45 degree fundus photograph, posterior pole photograph, 848x848, NIDEK AFC-230 fundus camera:
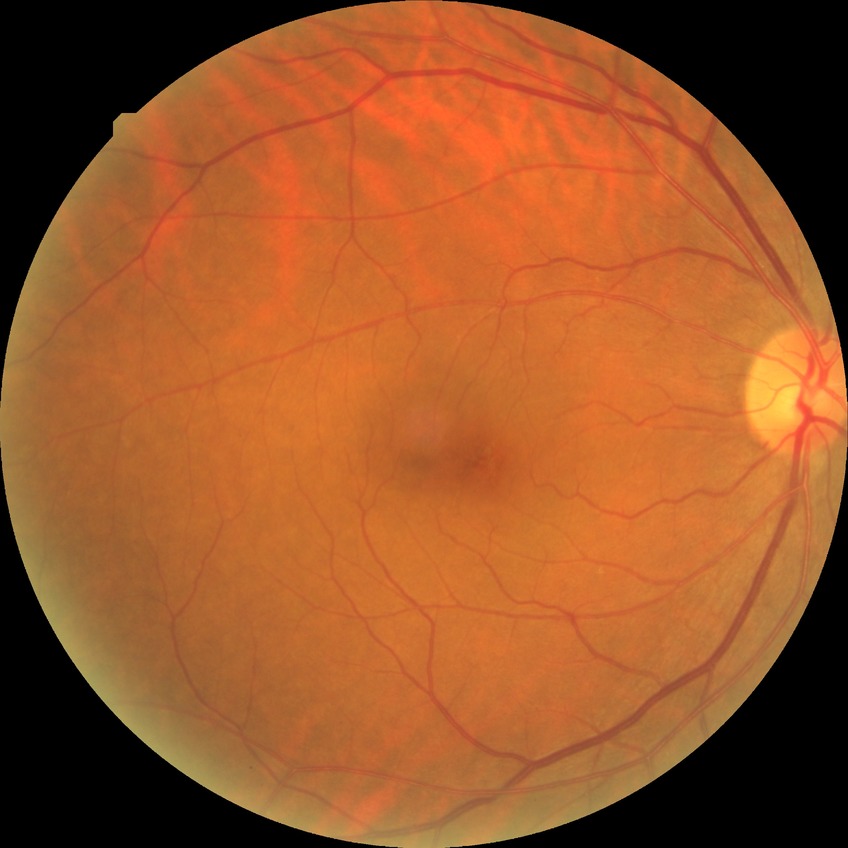

Diabetic retinopathy stage is no diabetic retinopathy.